Posterior pole view
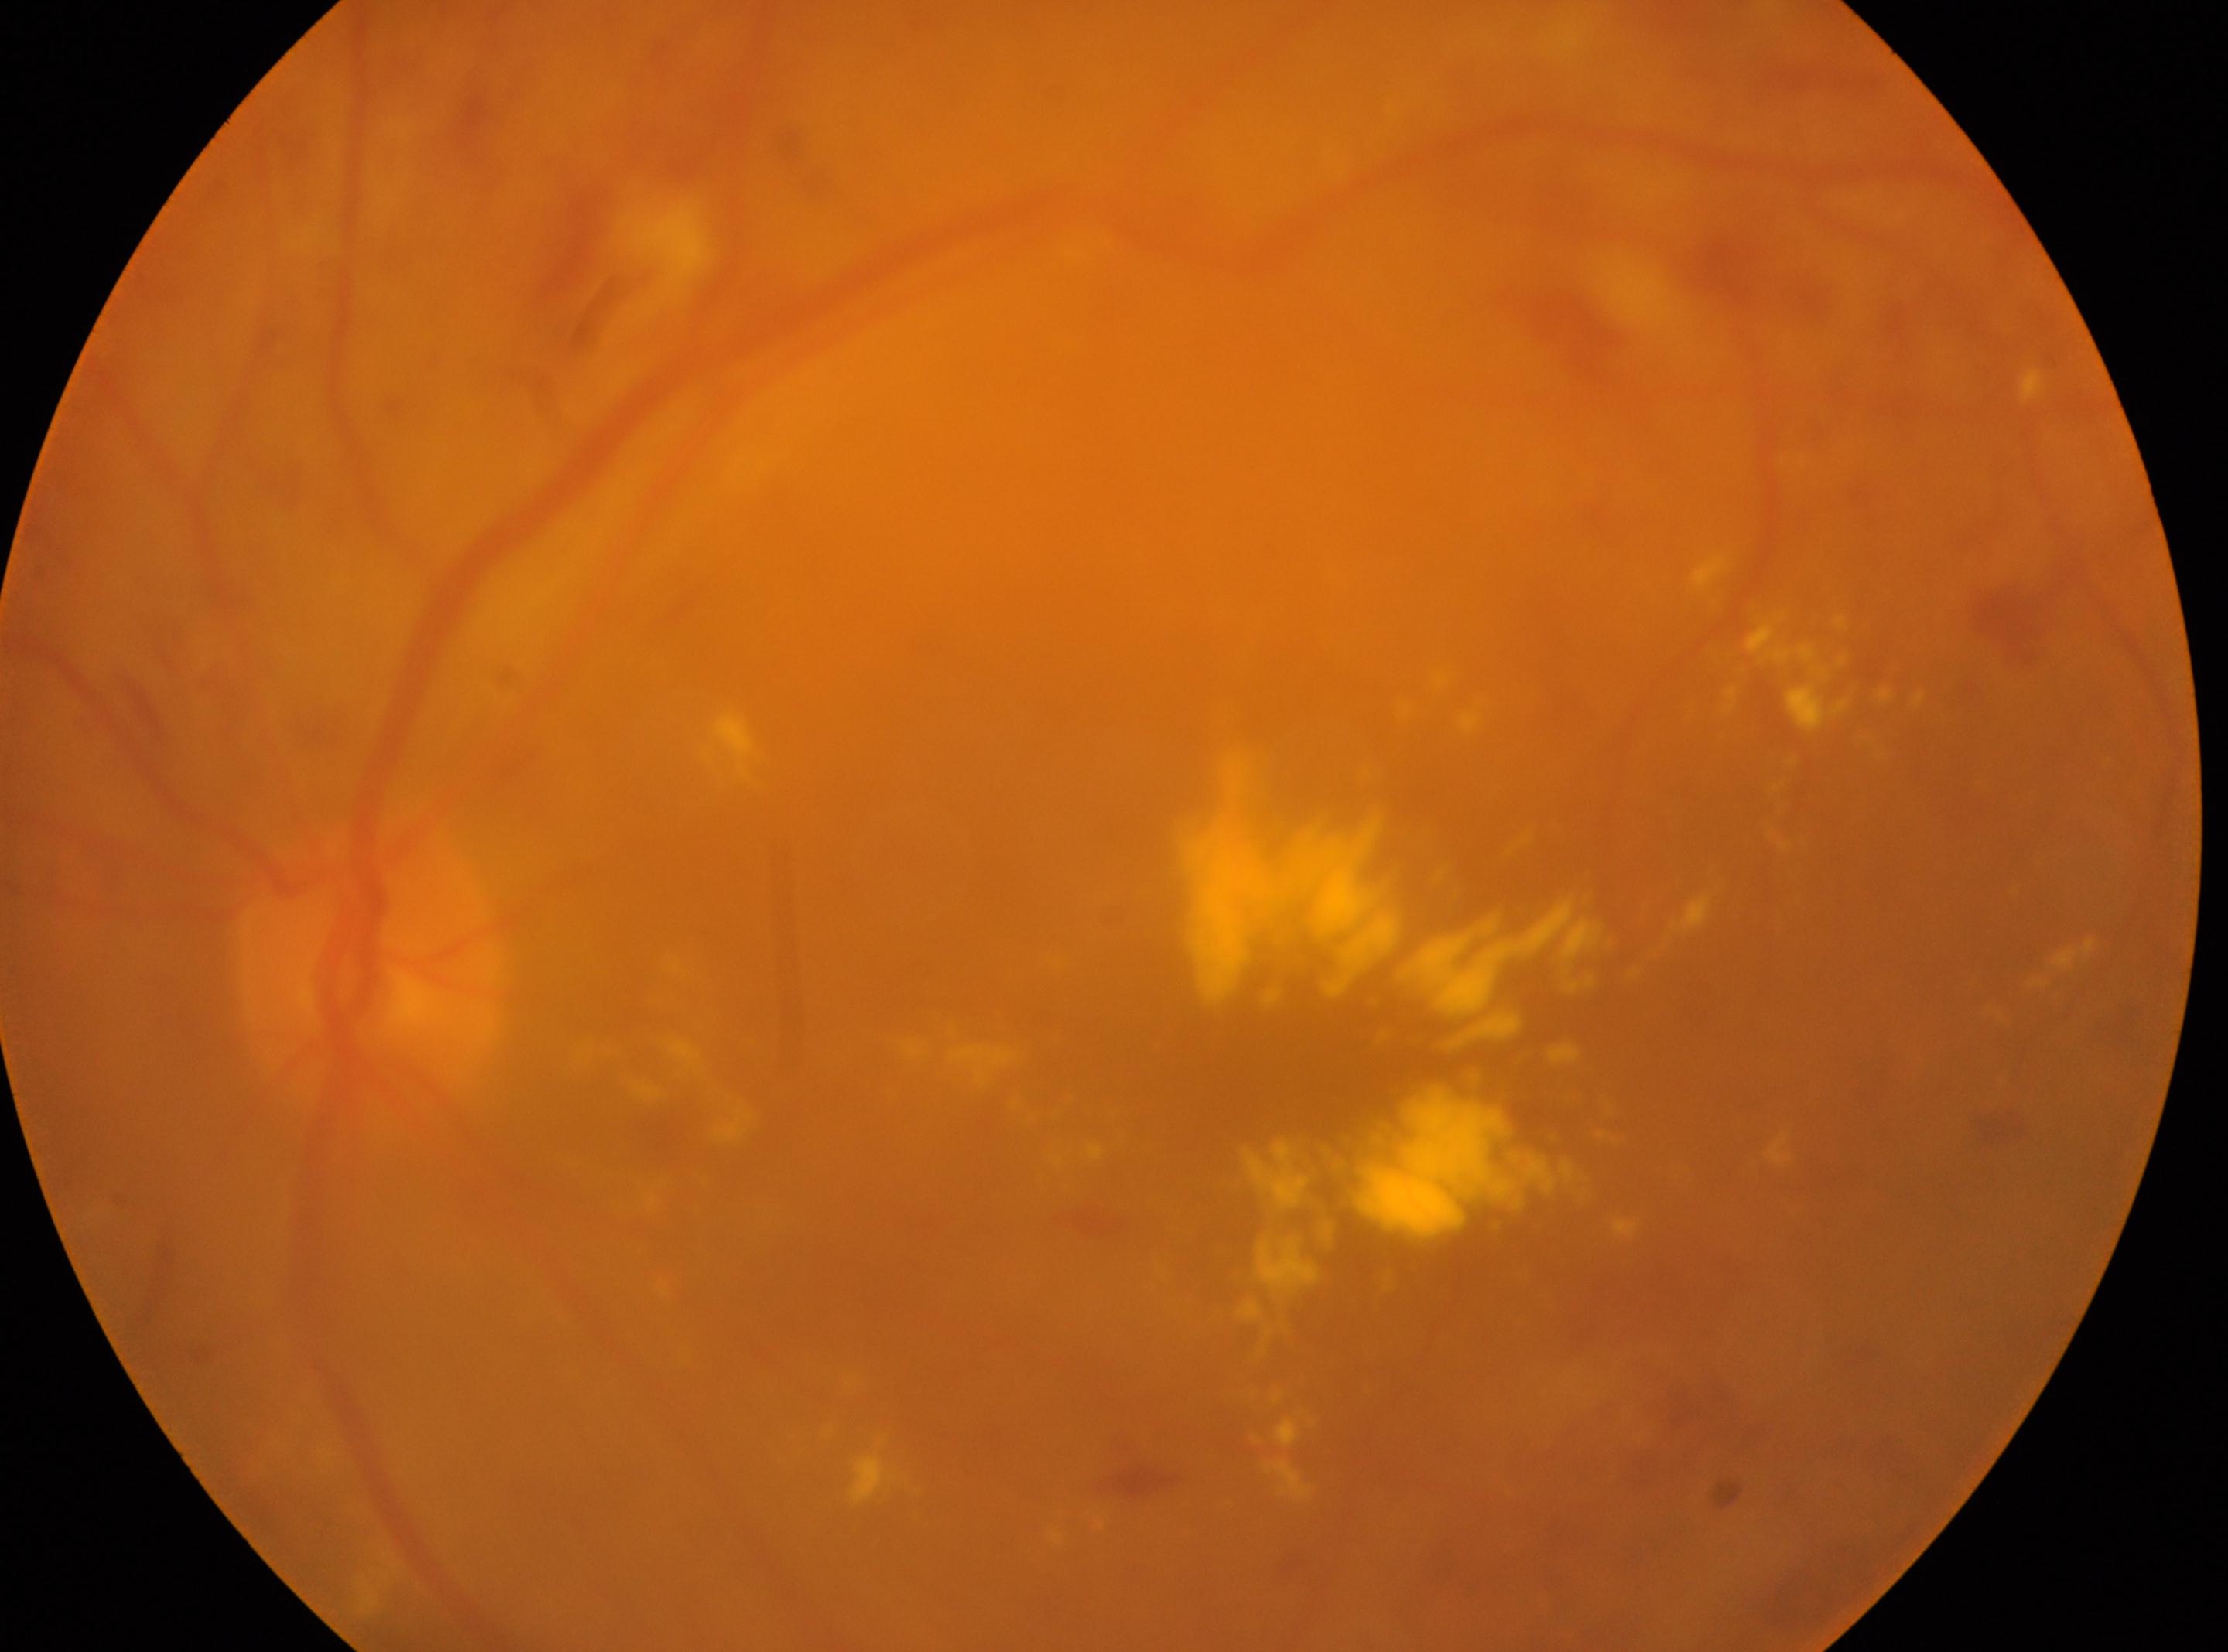 the optic disc=369, 963
non-proliferative diabetic retinopathy
macula center=1233, 1094
diabetic retinopathy grade=2/4
left